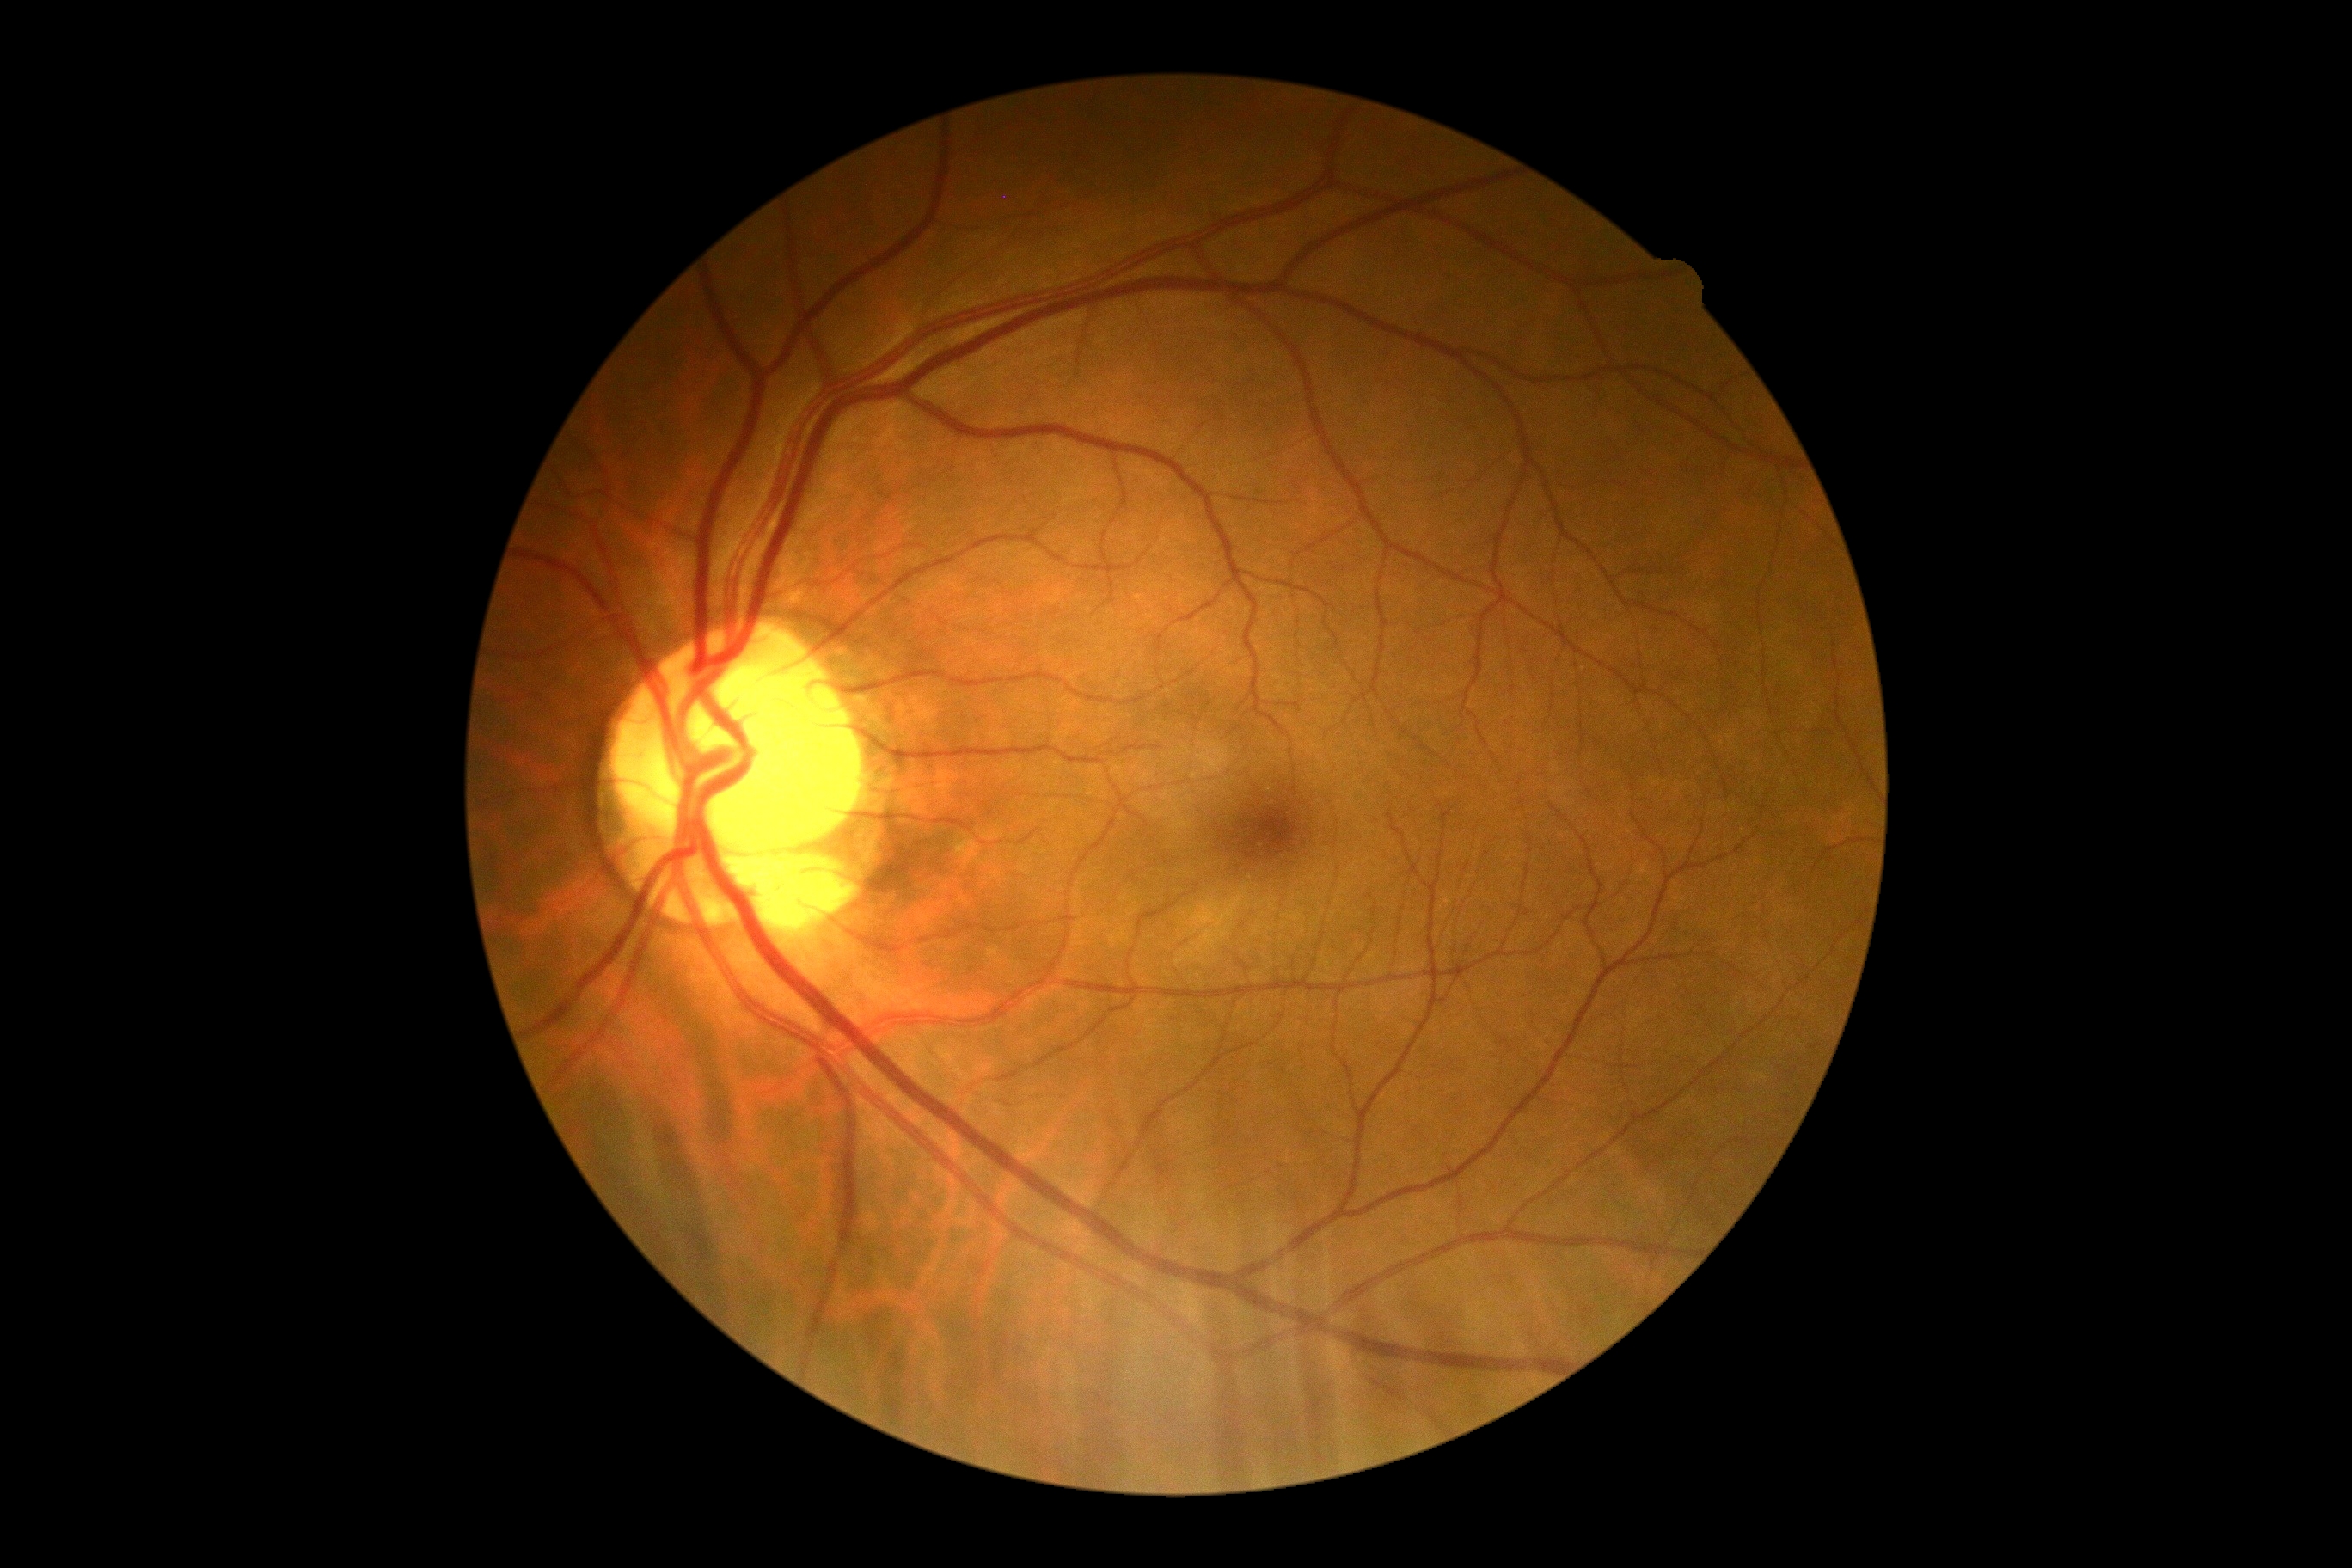 retinopathy=no apparent retinopathy (grade 0).